2352 x 1568 pixels: 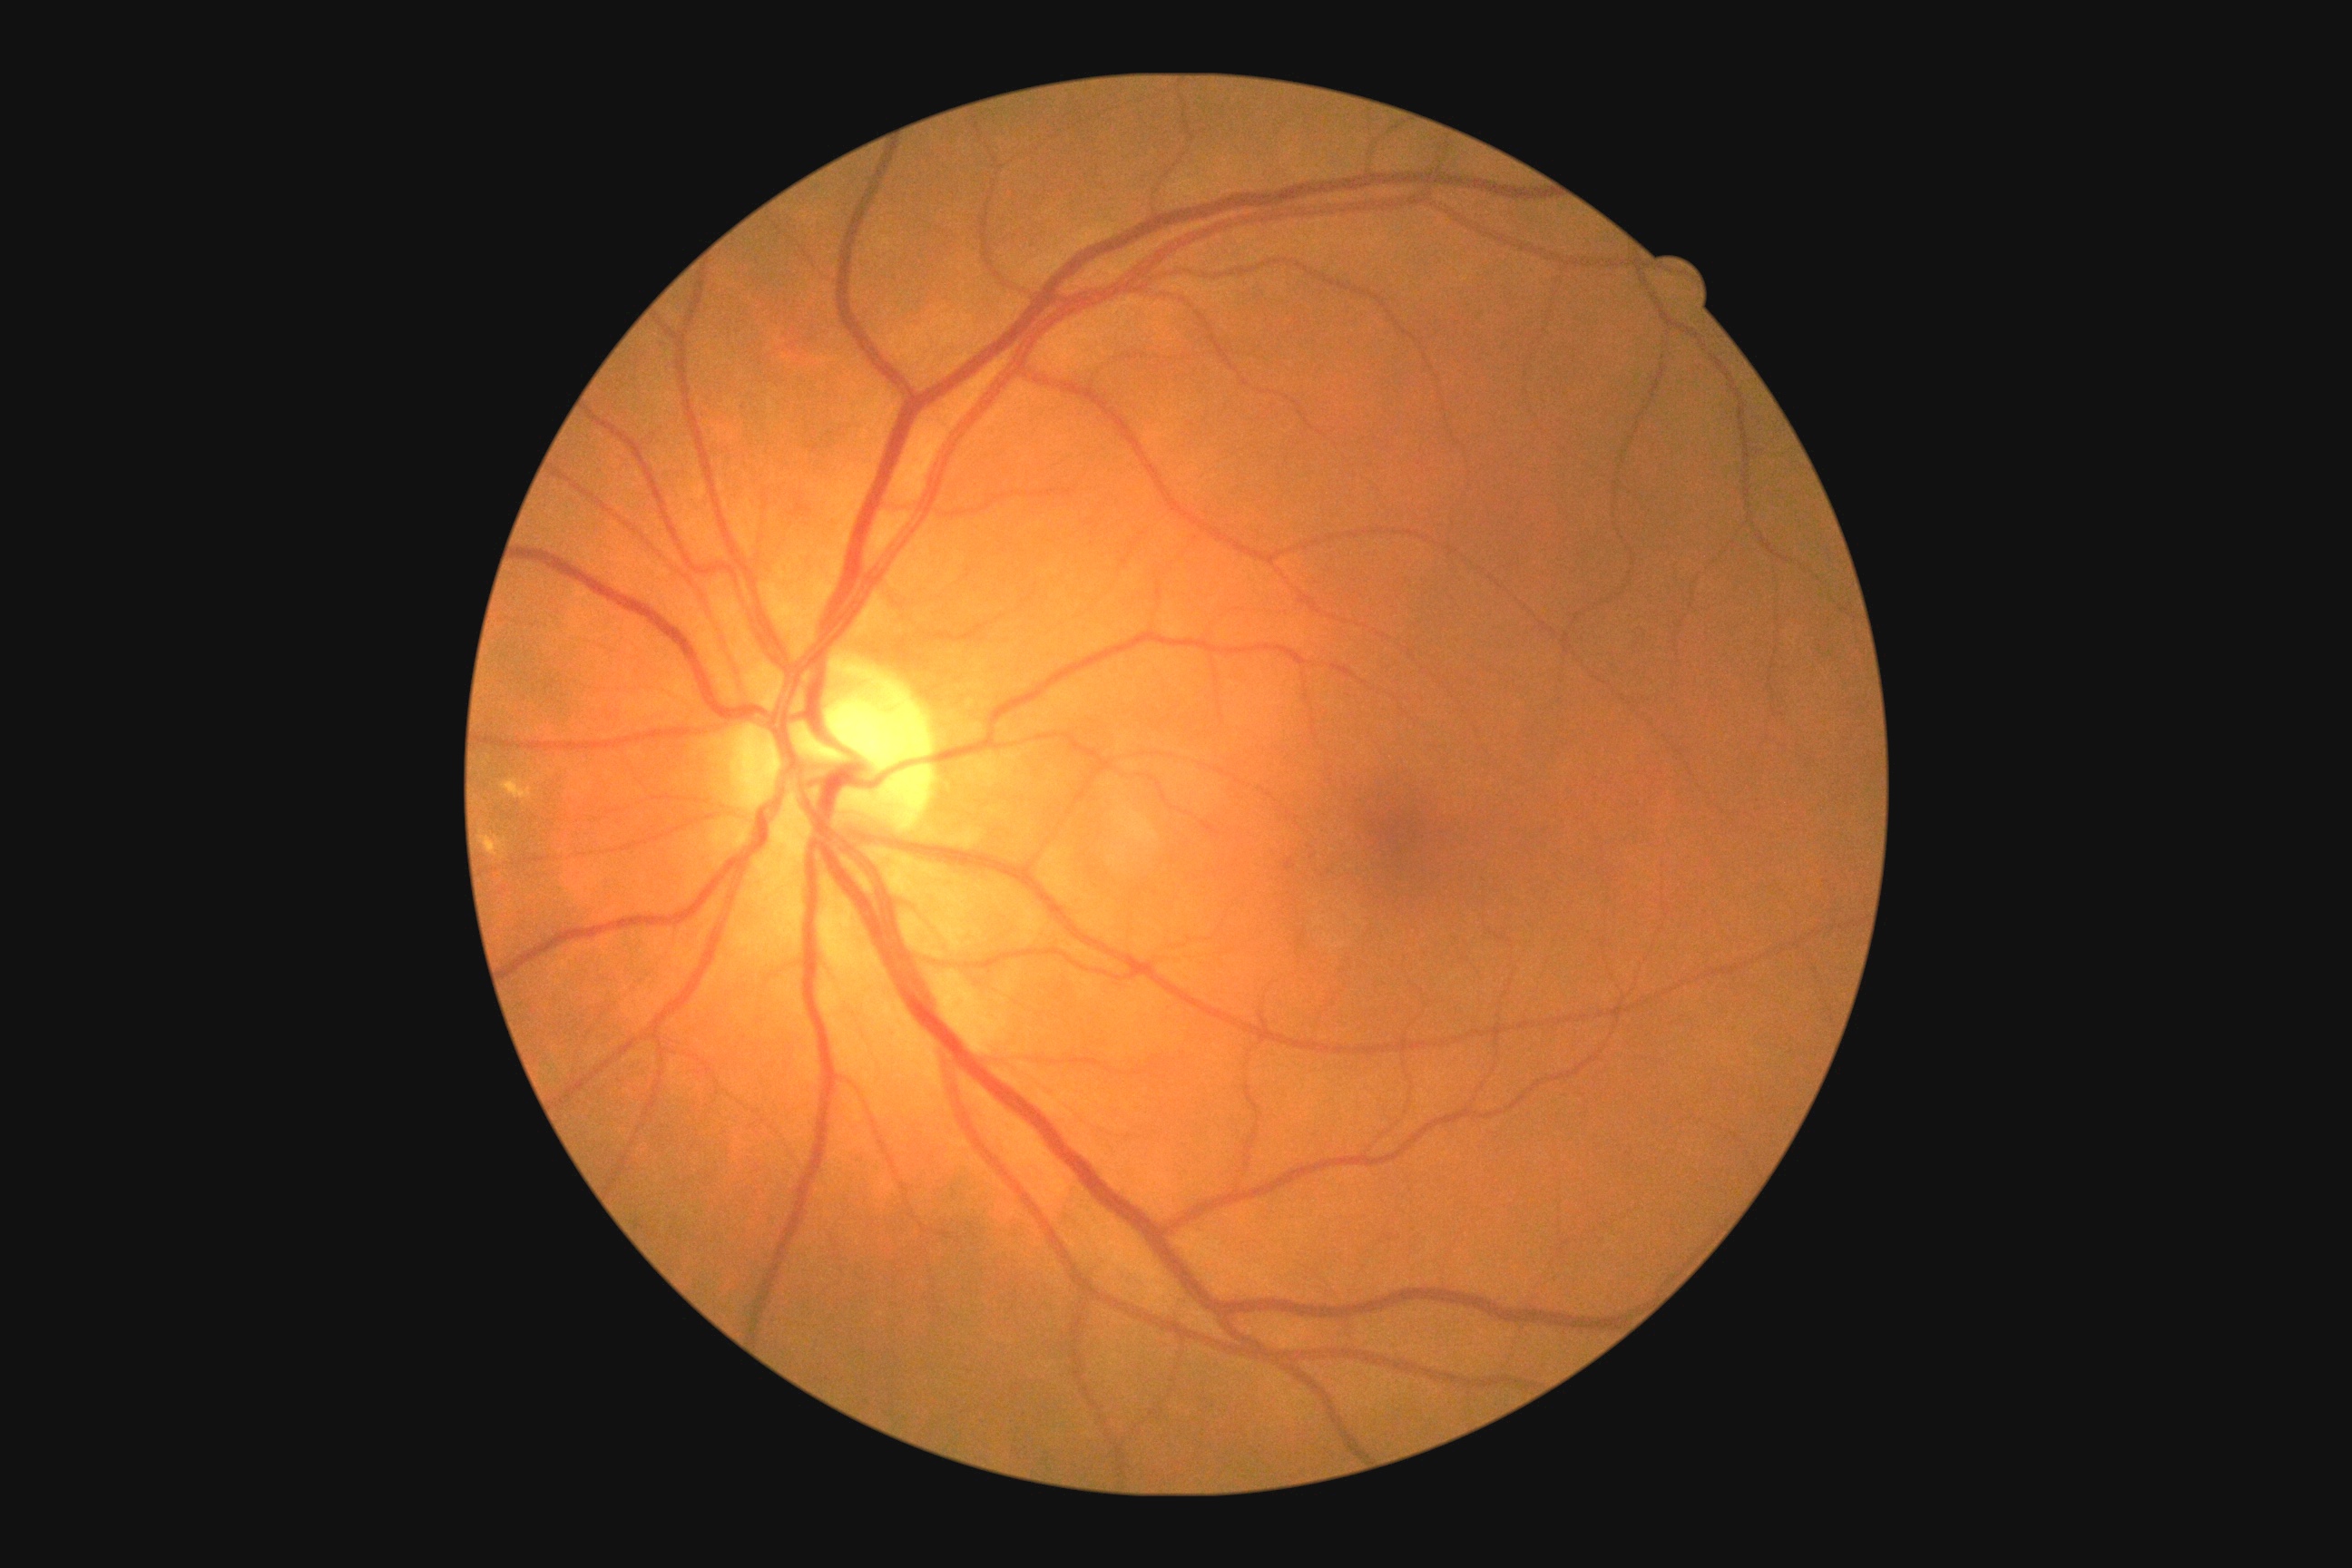

diabetic retinopathy severity: moderate non-proliferative diabetic retinopathy (grade 2)